Infant wide-field retinal image.
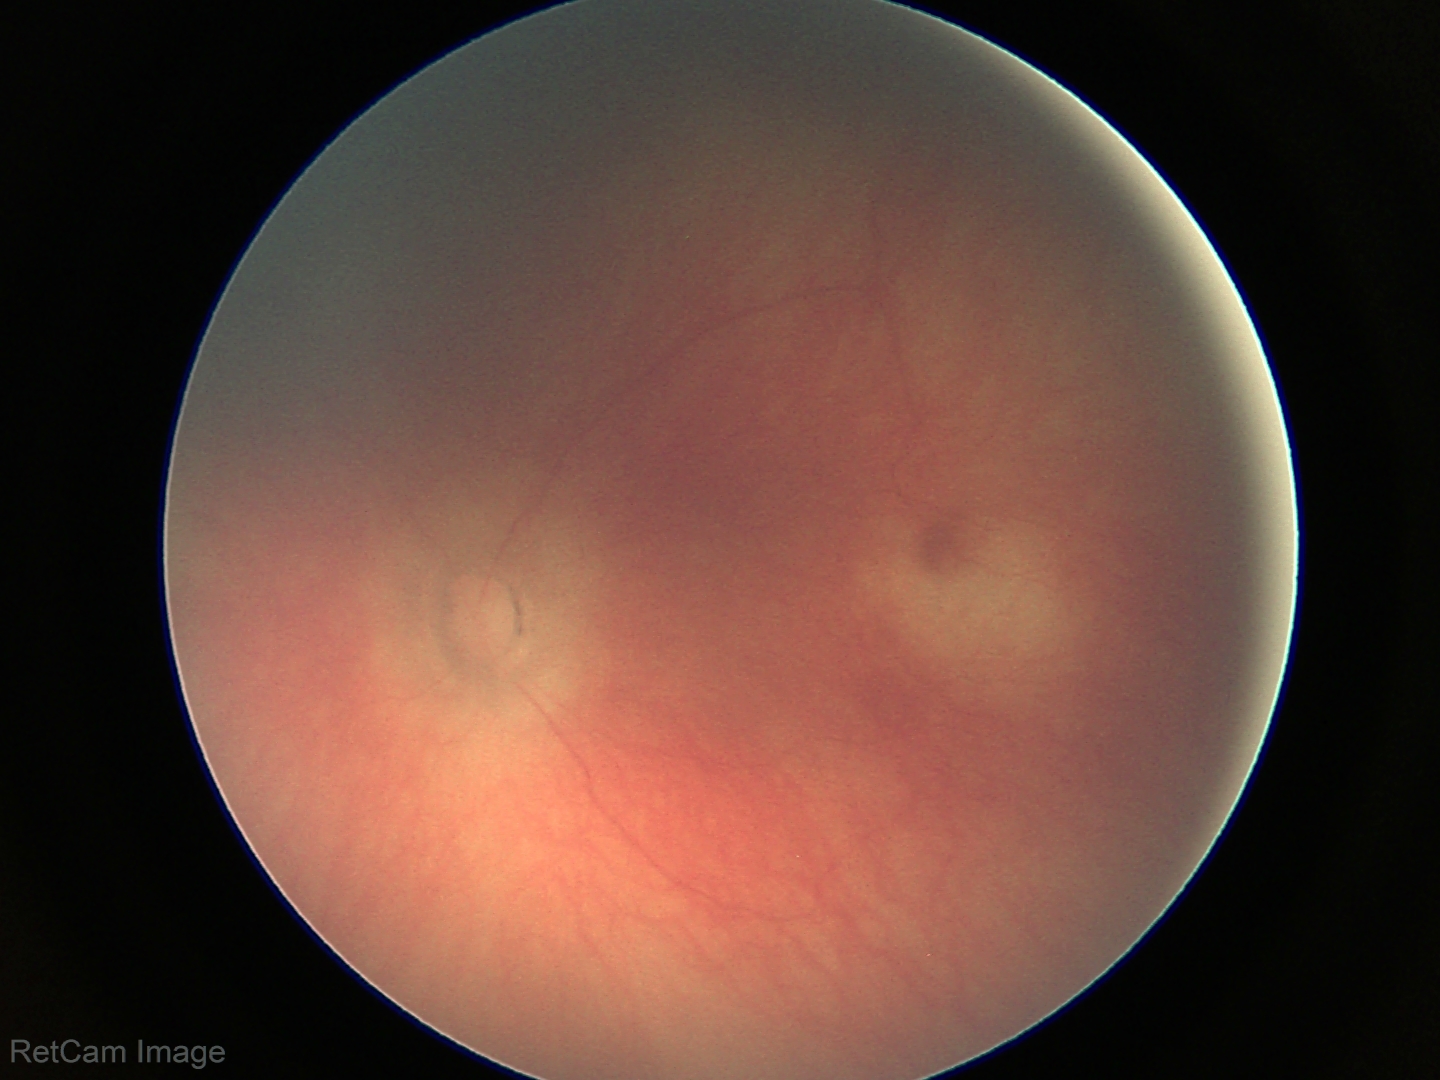

Screening: normal retinal appearance.